45° FOV: 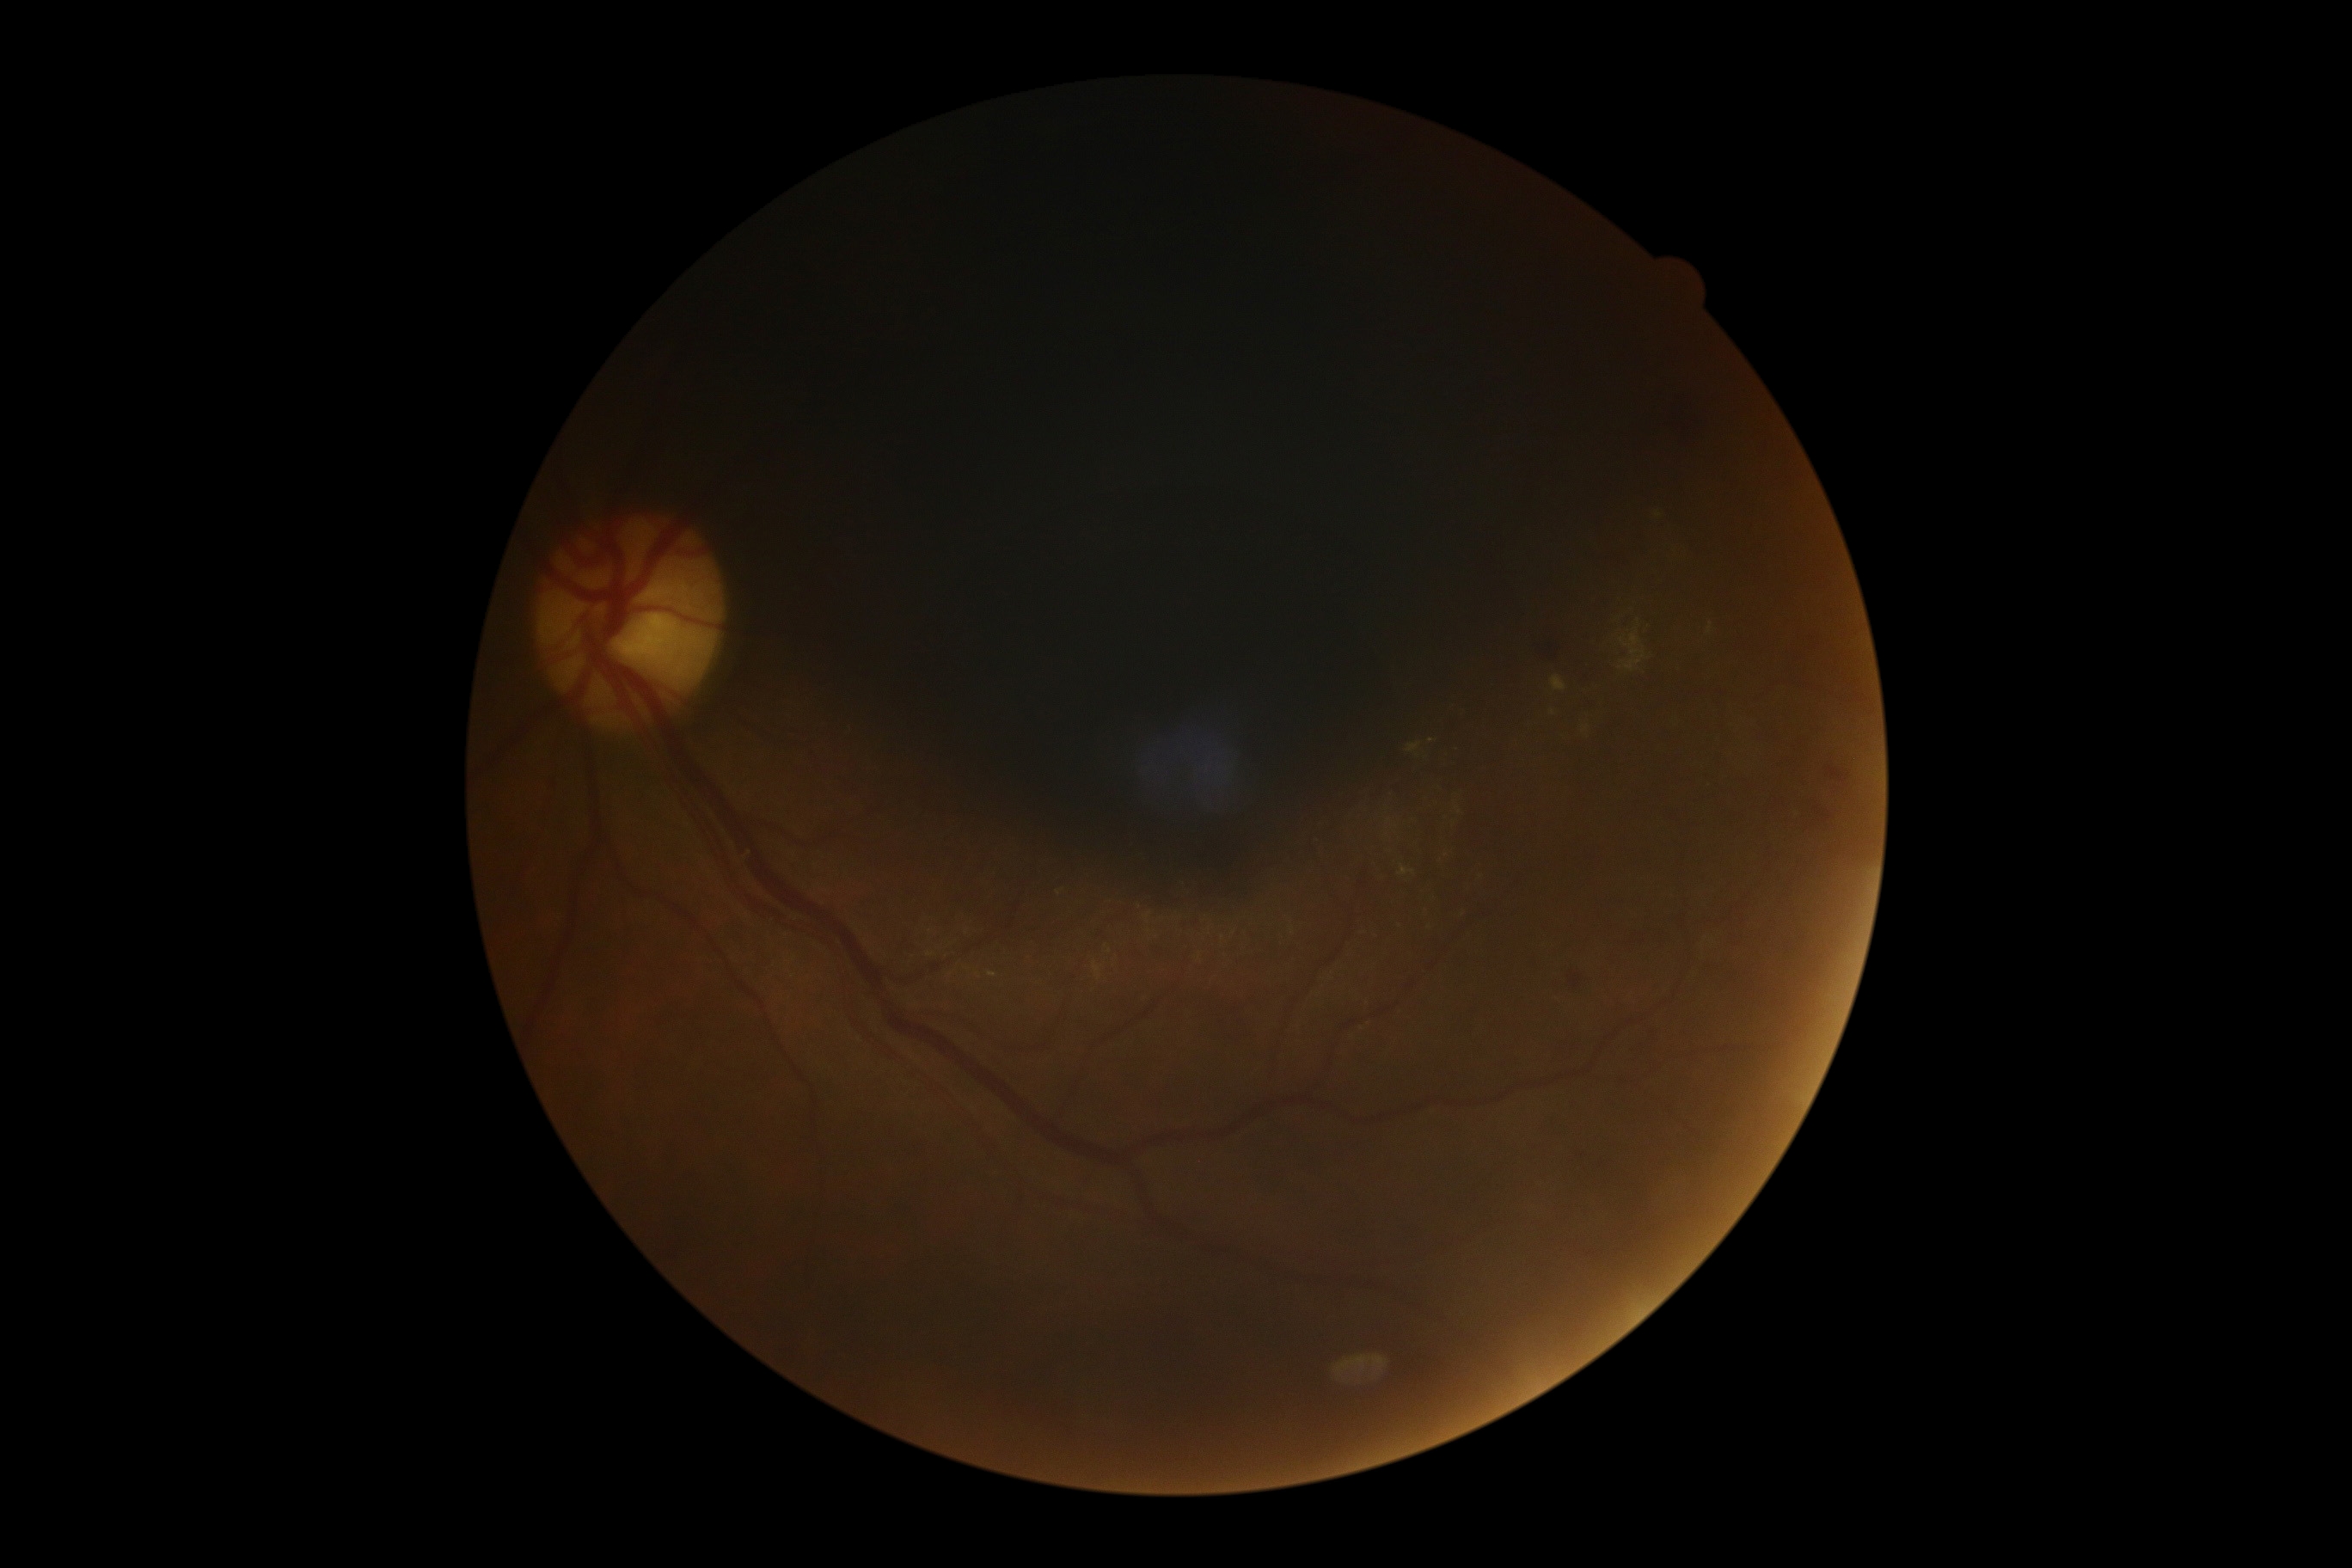

Findings:
– diabetic retinopathy: moderate NPDR (grade 2)